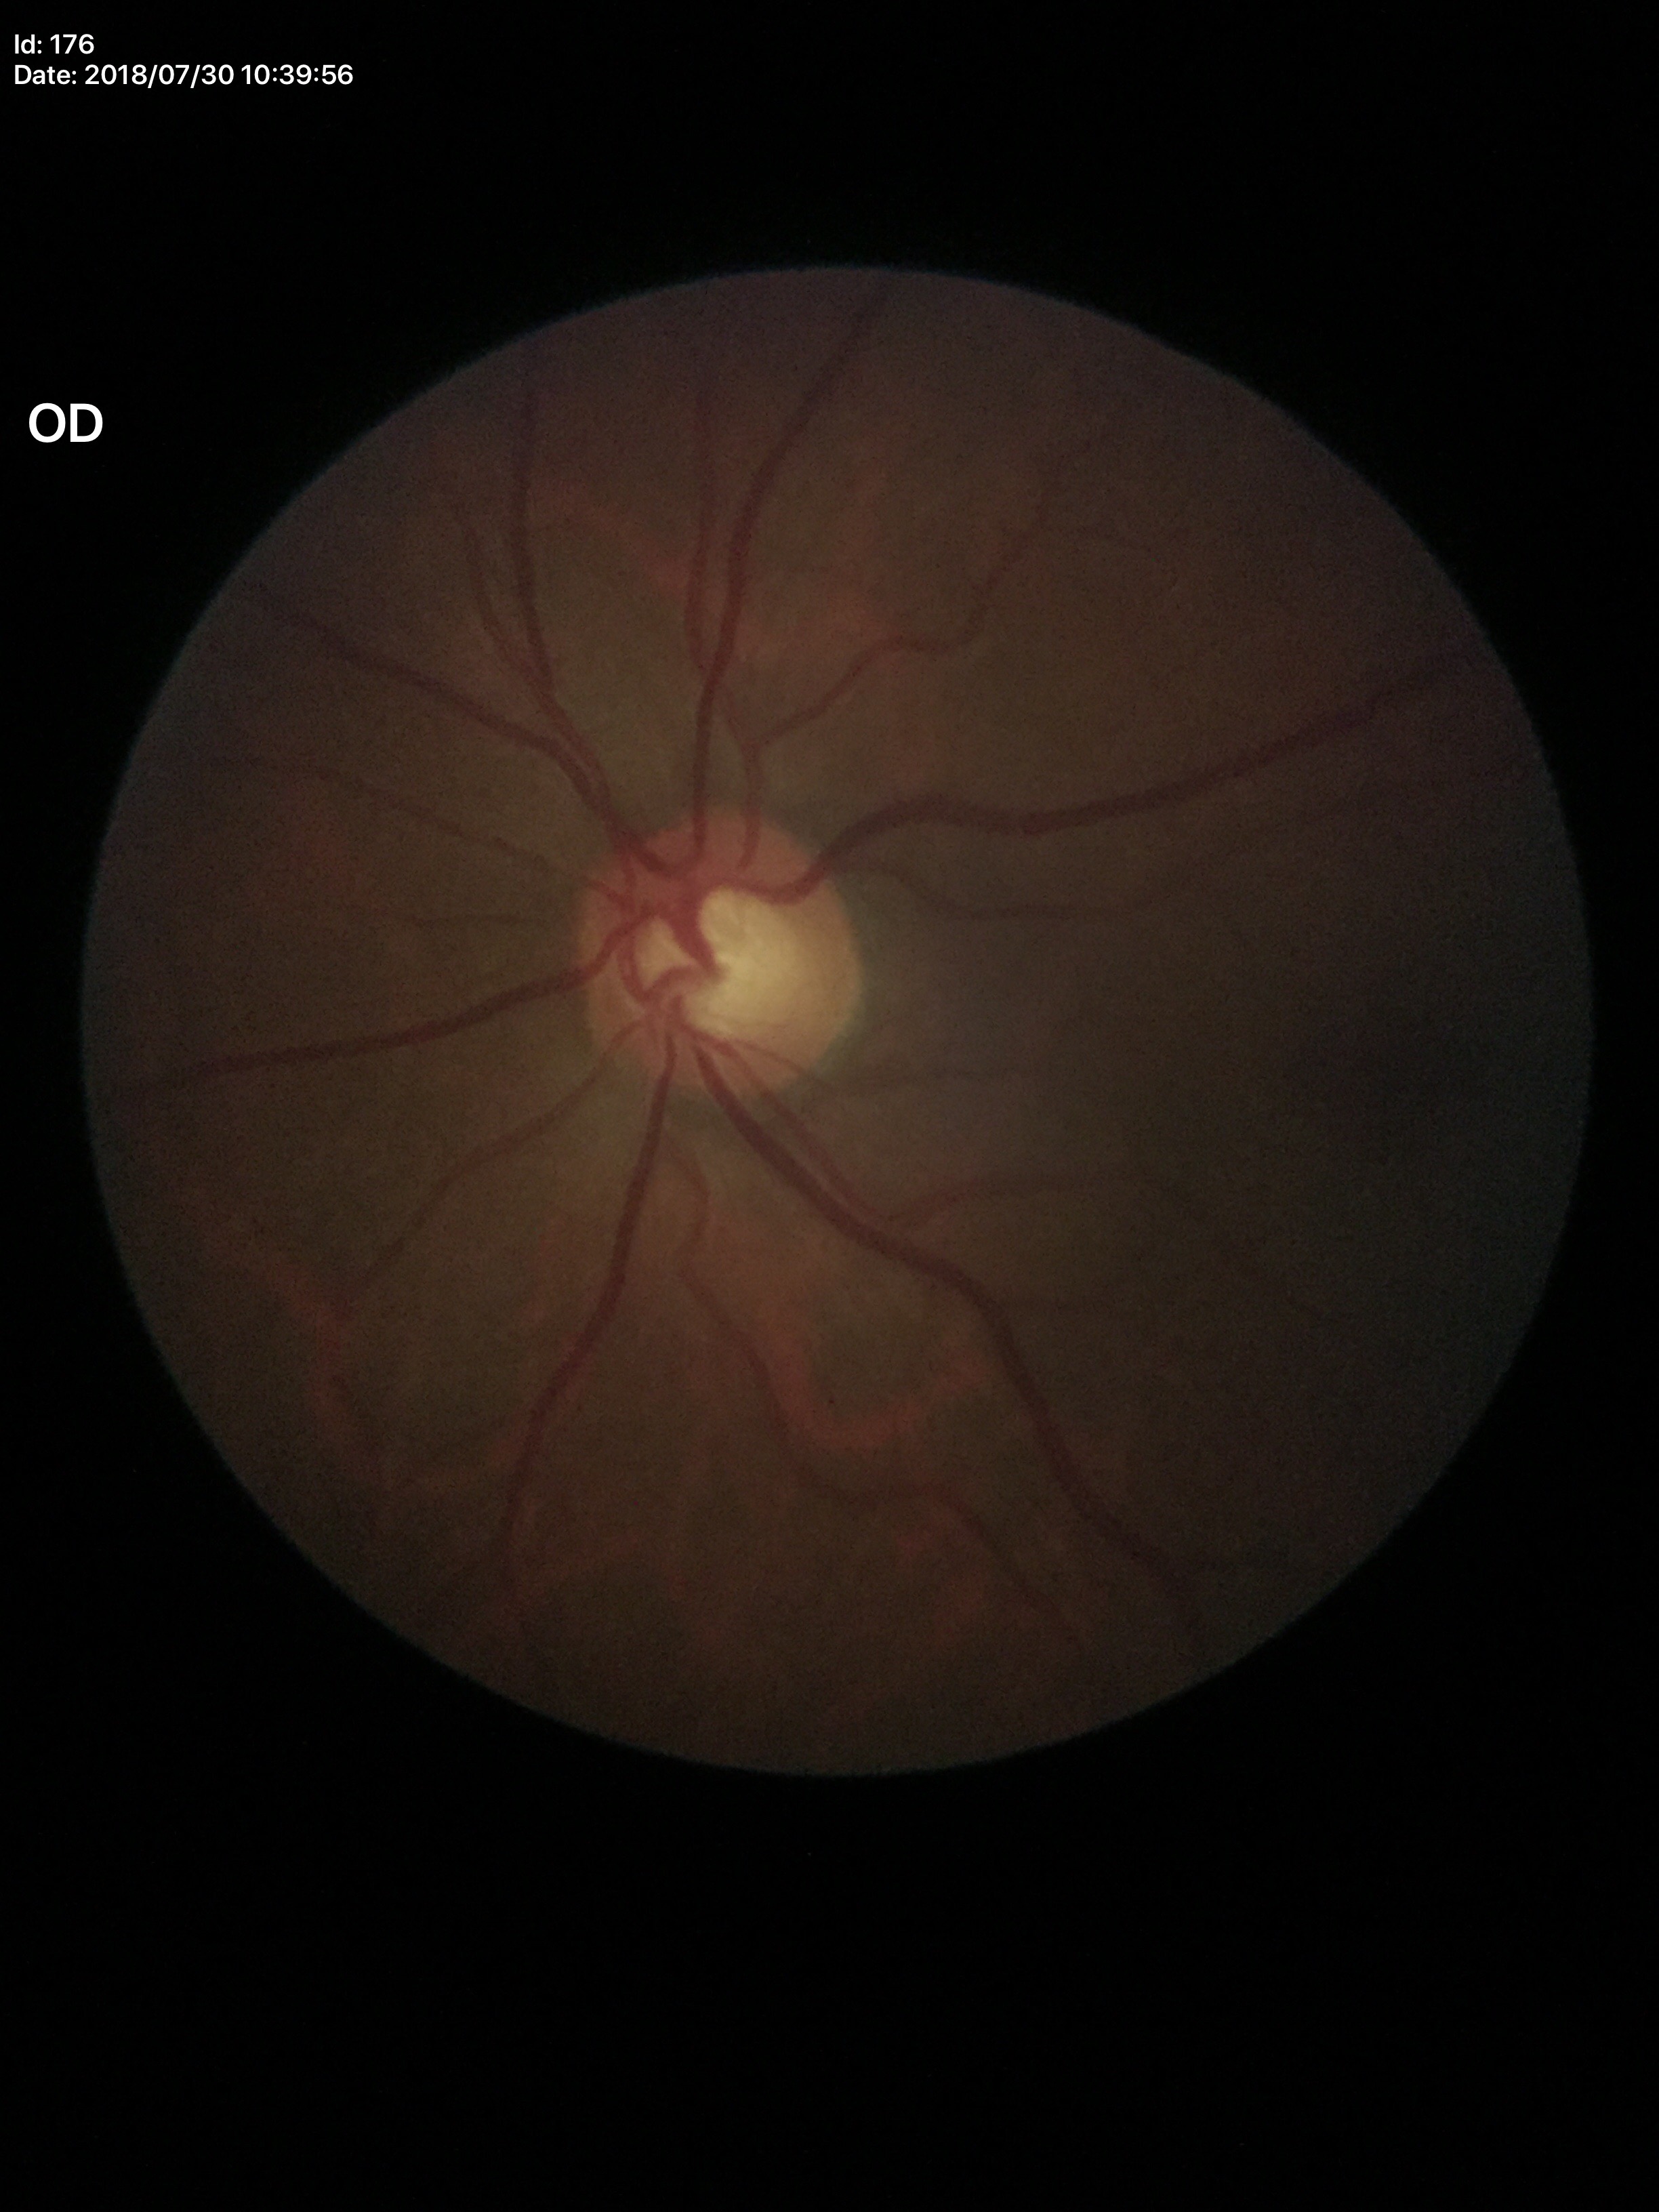
Glaucoma evaluation = no suspicious findings; vertical C/D ratio = 0.59; horizontal cup-to-disc ratio = 0.59.